Optic disc-centered crop: 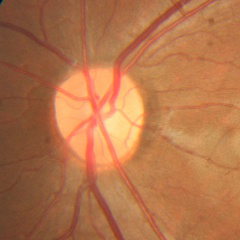
Q: Does this eye have glaucoma?
A: No glaucoma.